Color fundus image.
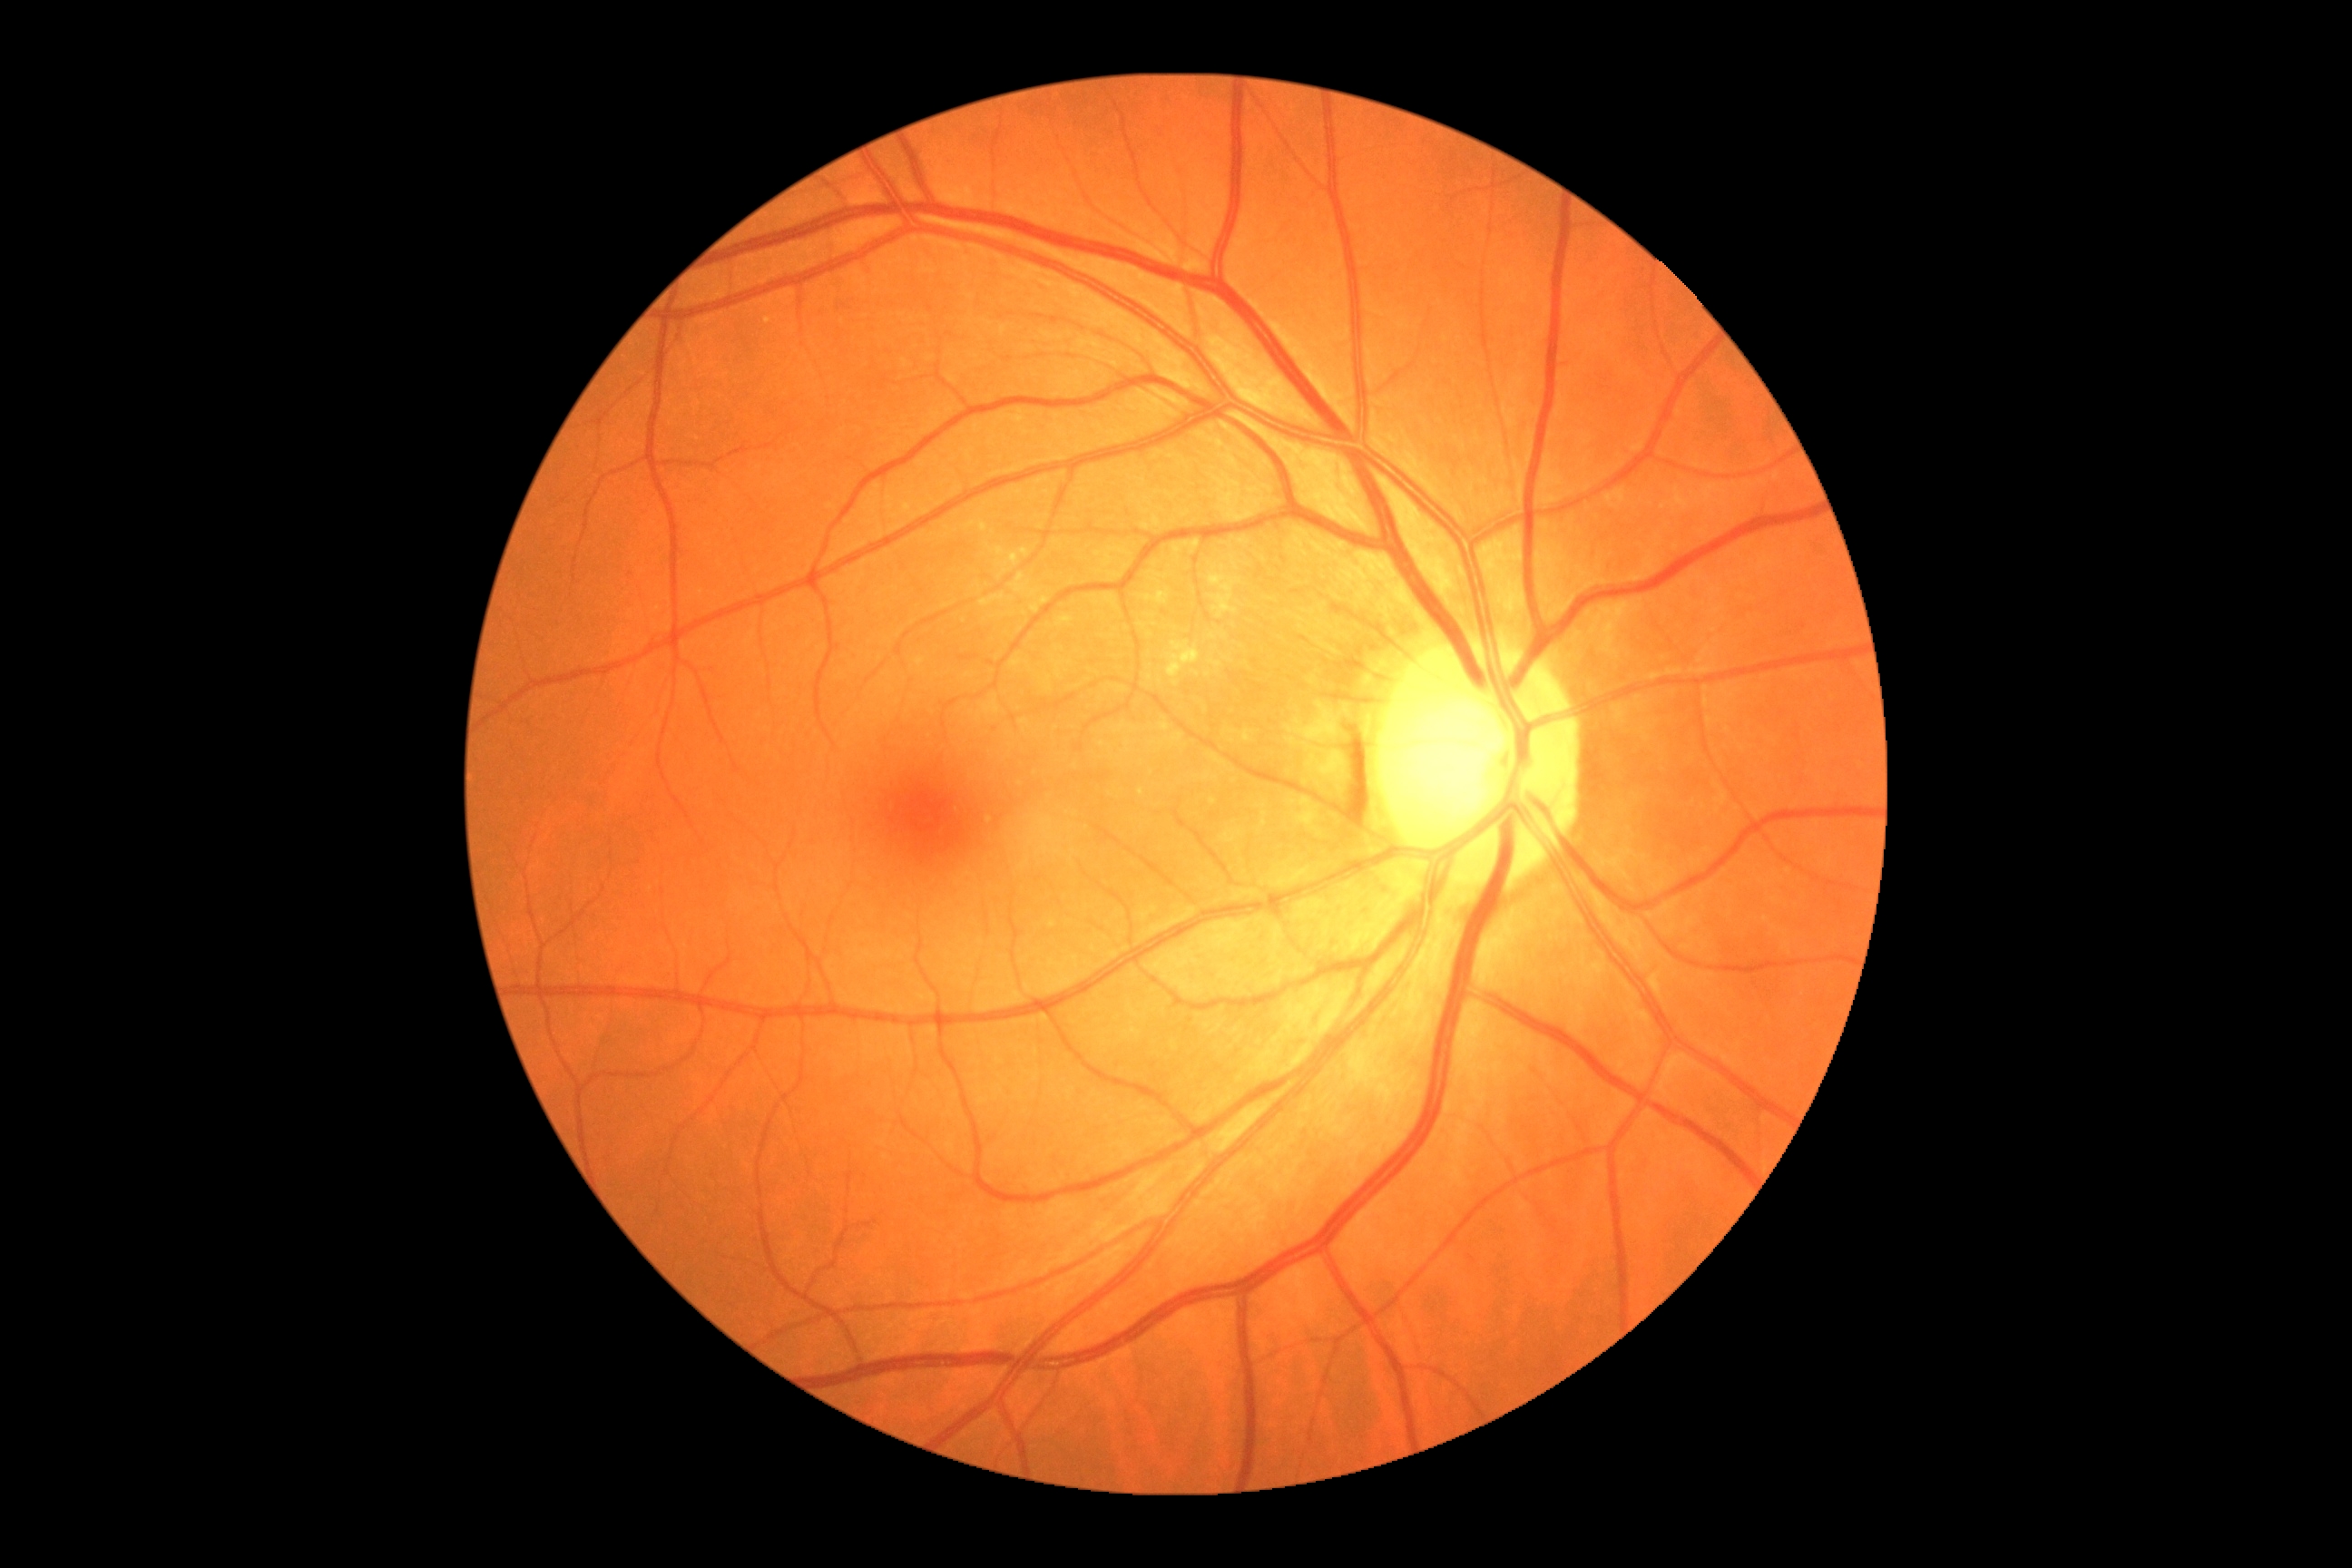
Annotations:
* DR impression: no signs of DR
* DR grade: 0 (no apparent retinopathy)